45° field of view; 2048x1536px.
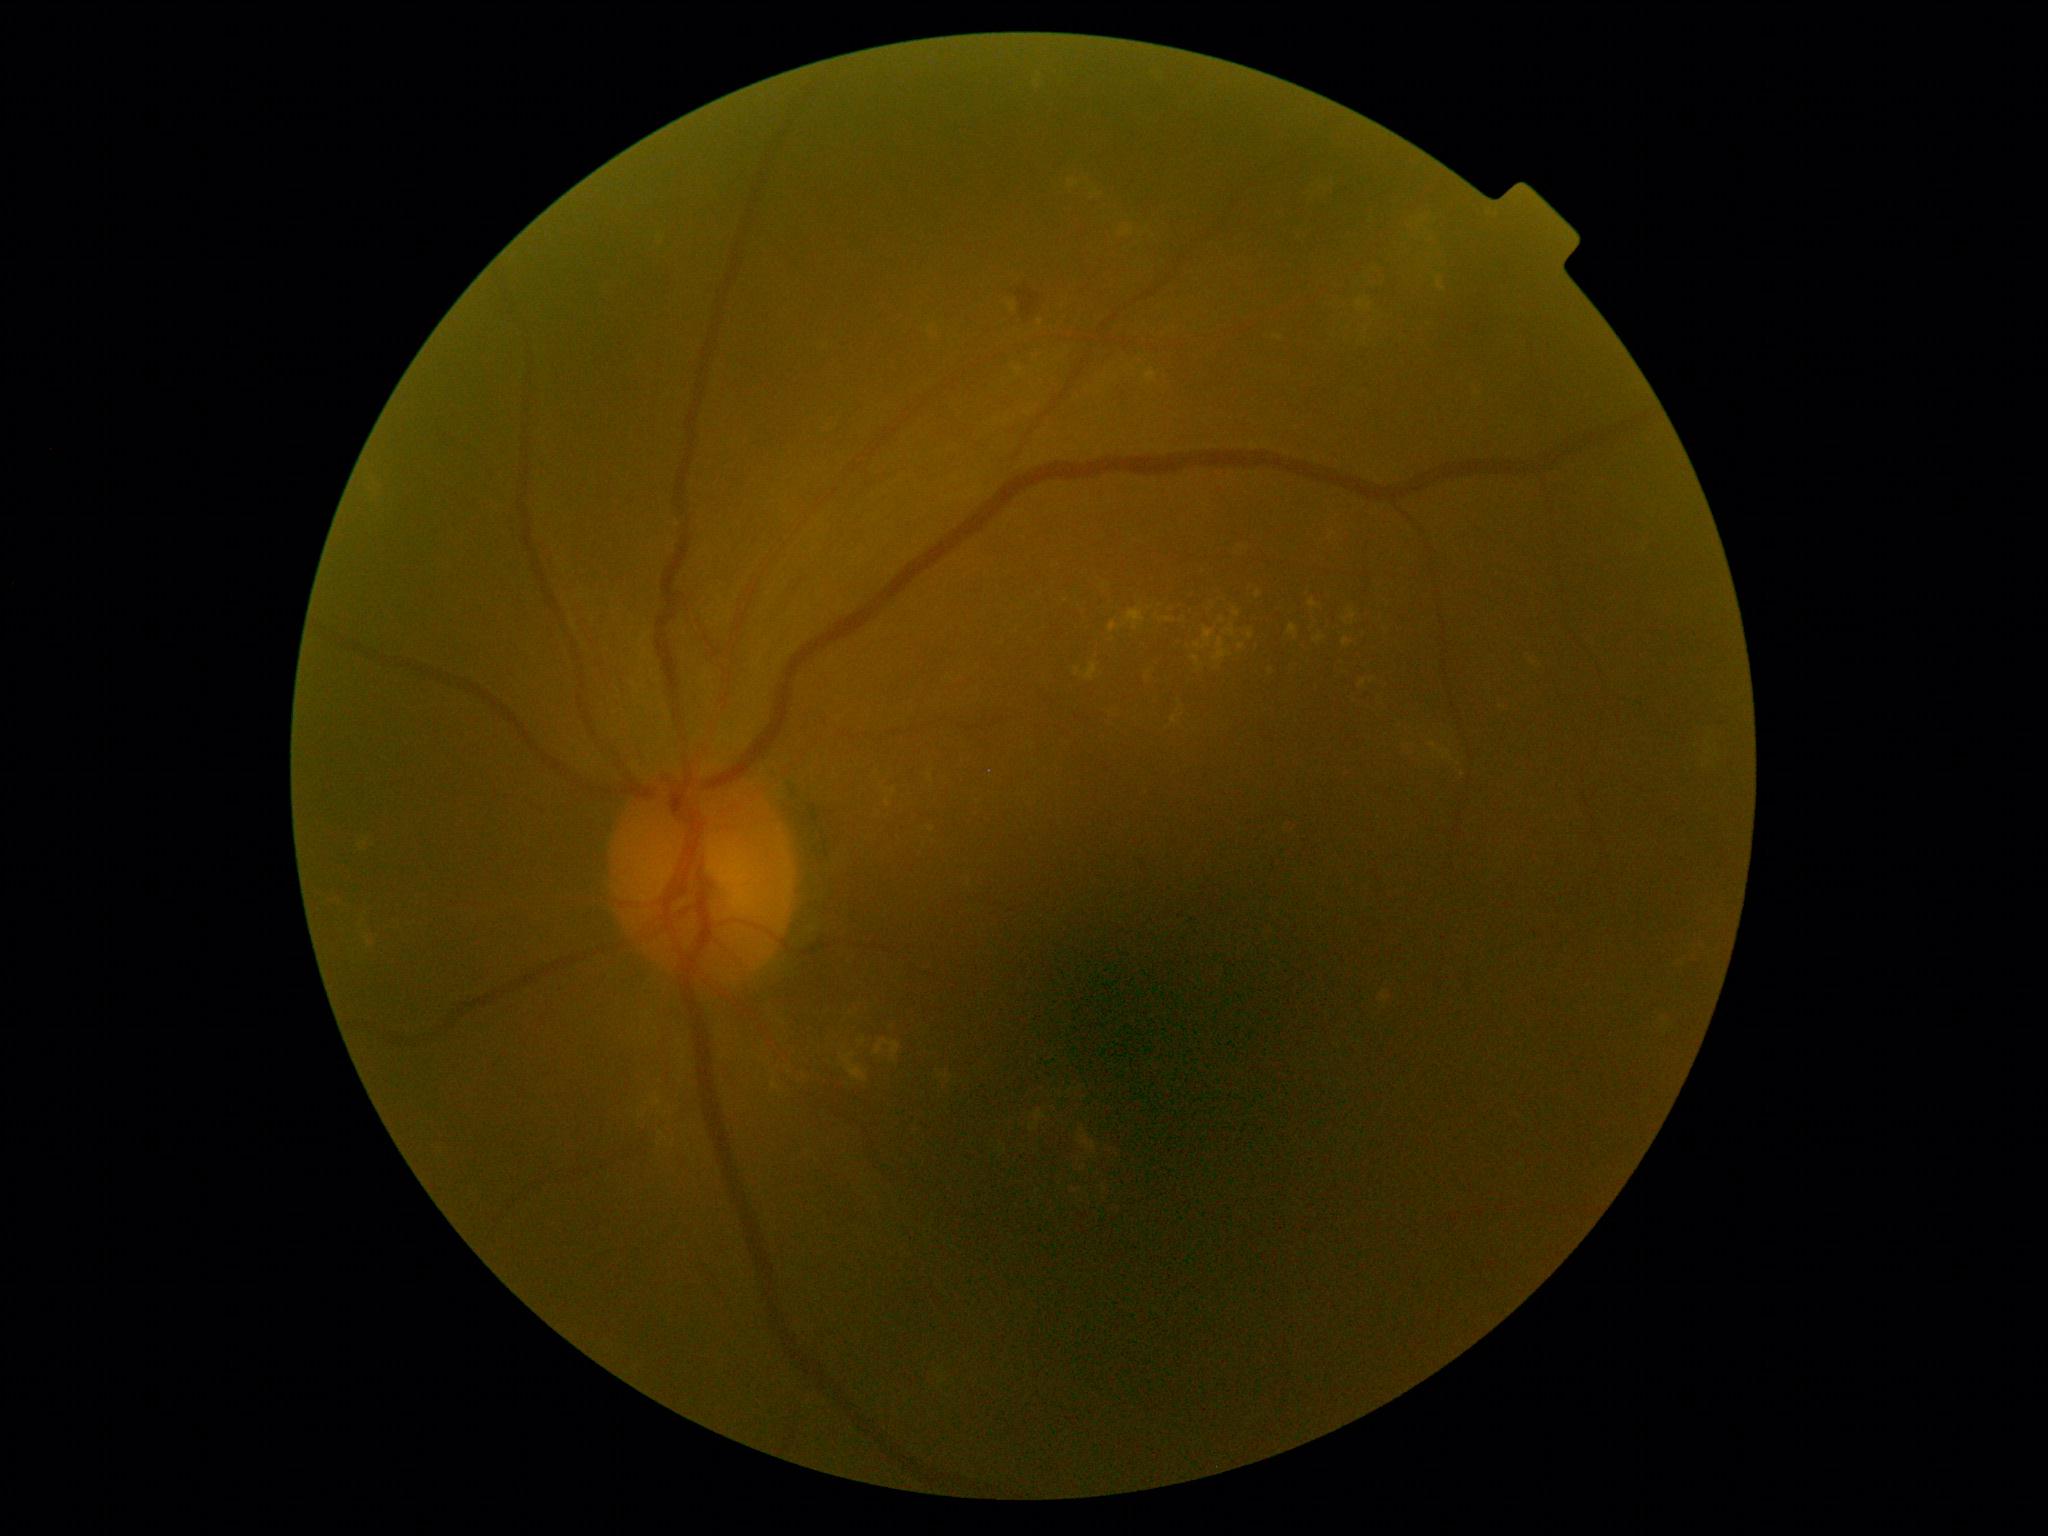
Diabetic retinopathy (DR): moderate NPDR (grade 2).